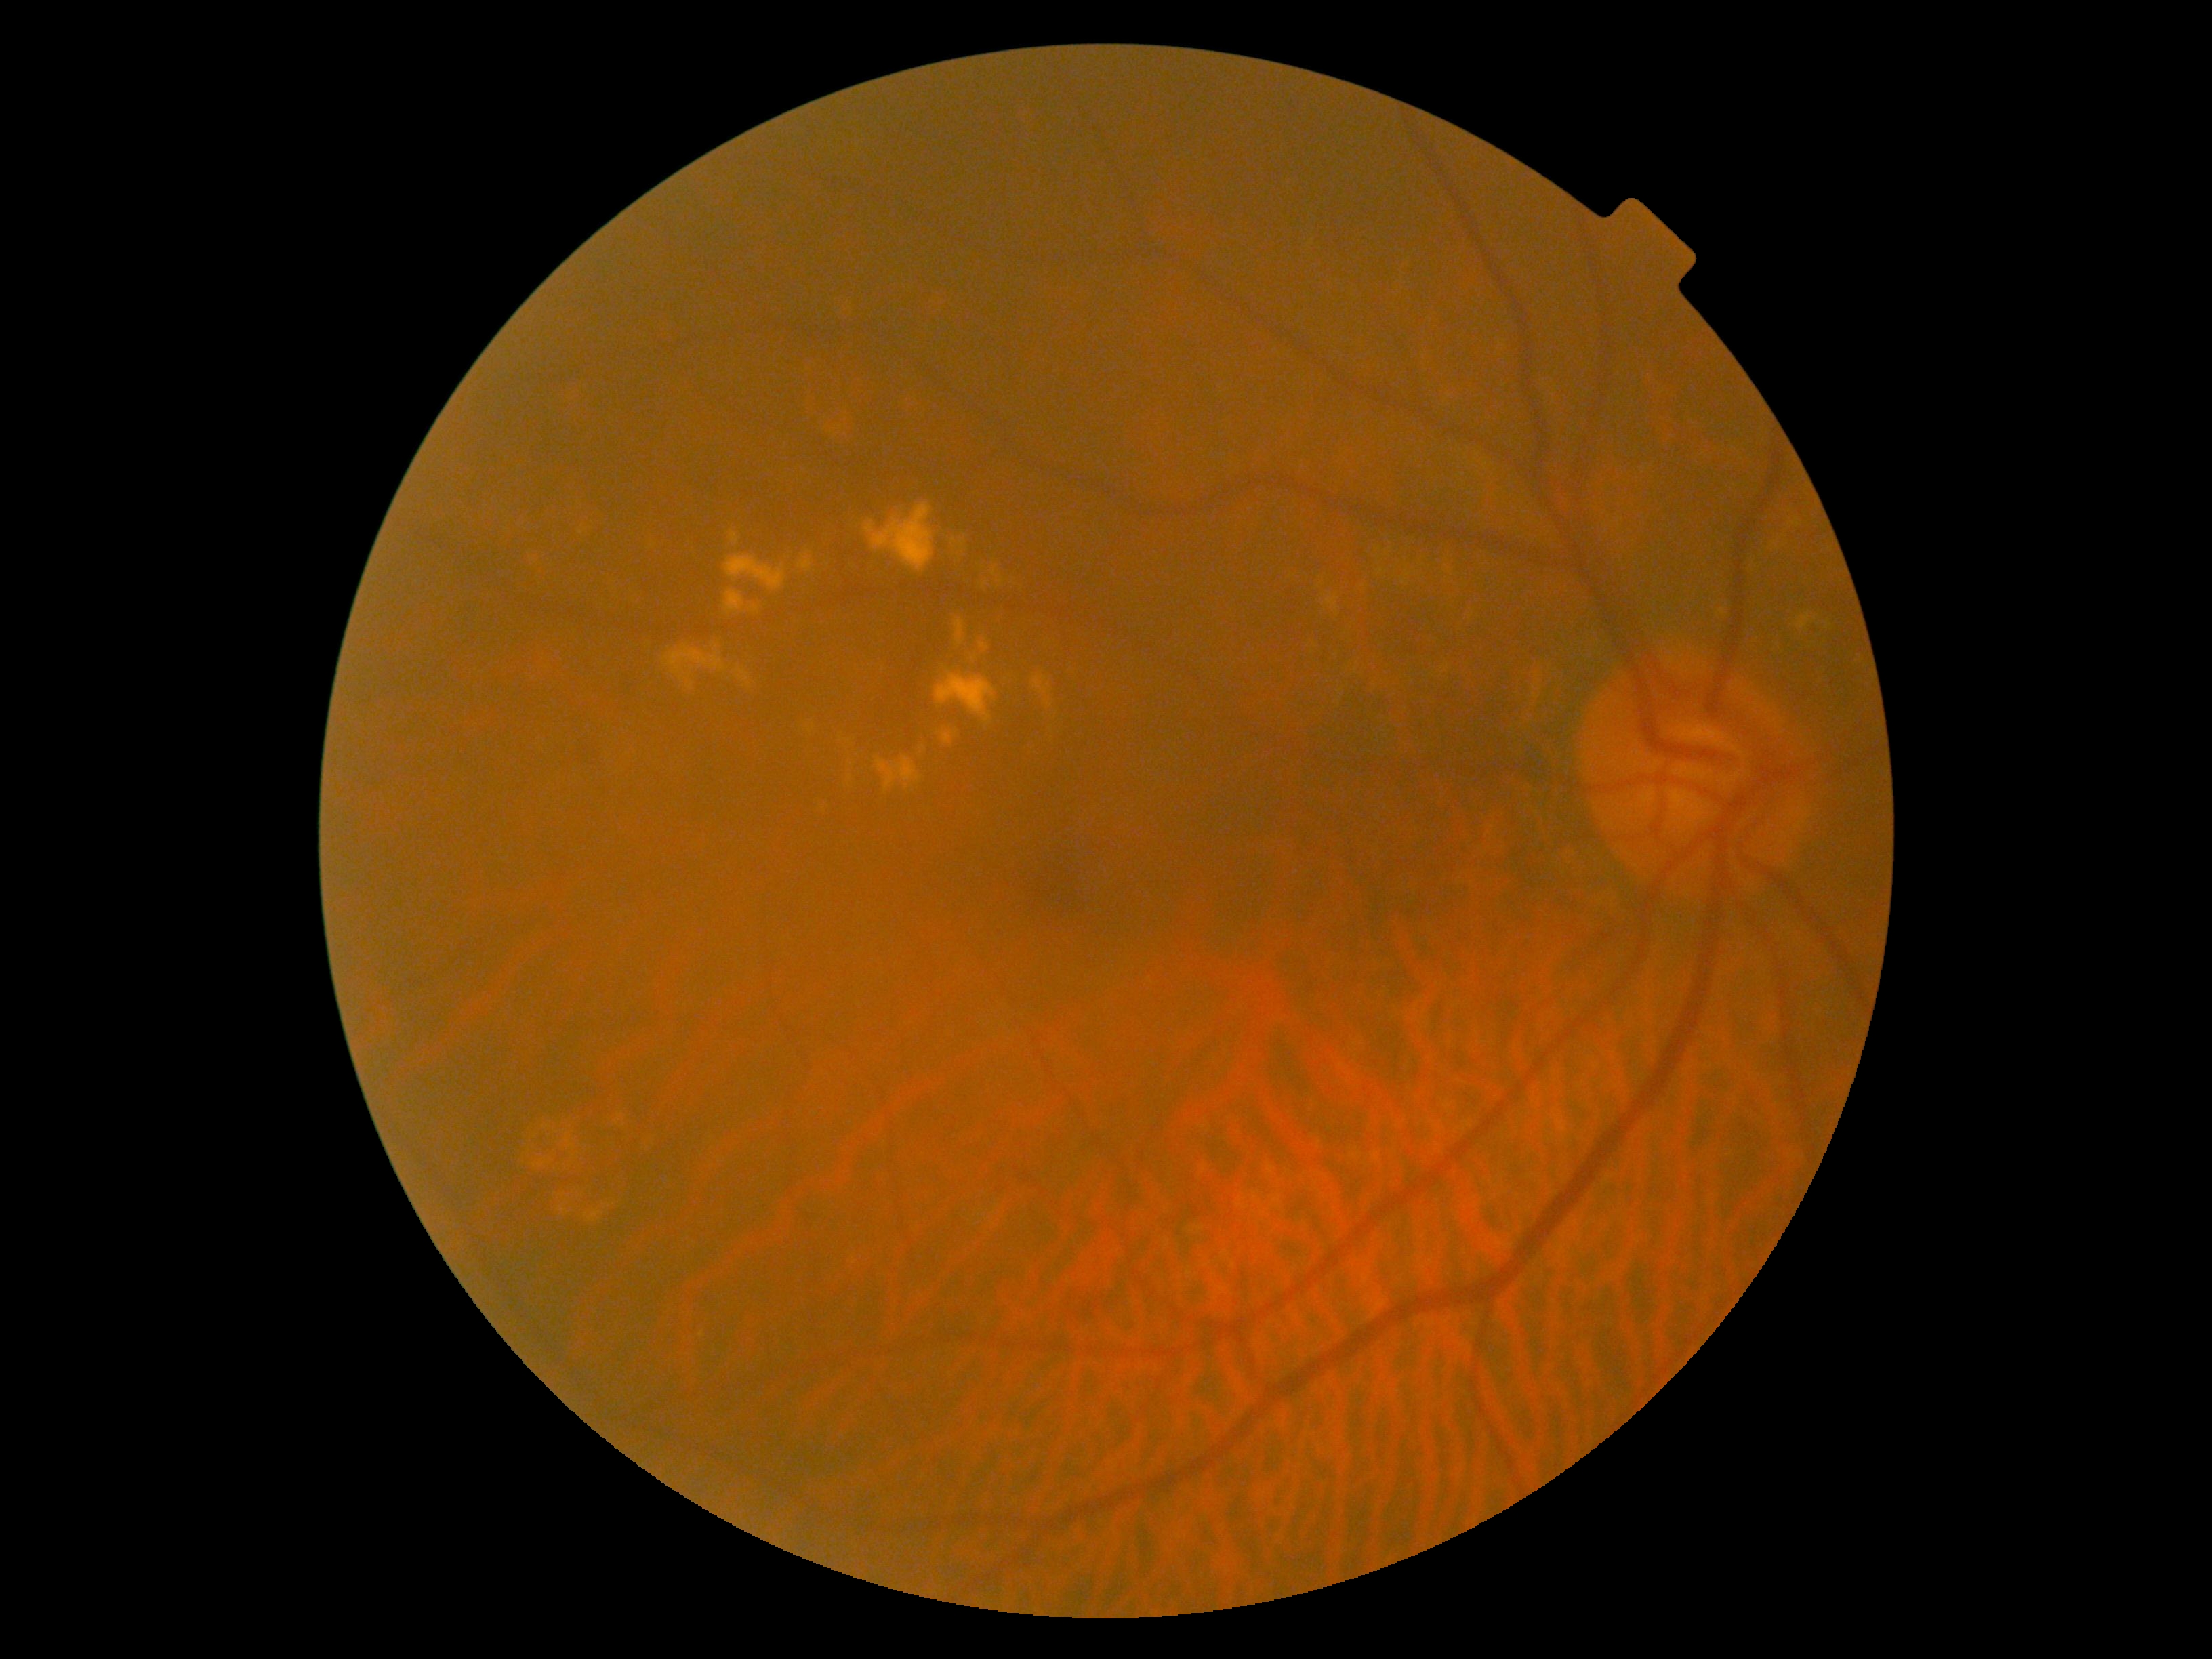
Diabetic retinopathy grade is moderate non-proliferative diabetic retinopathy (2).